DR severity per modified Davis staging: 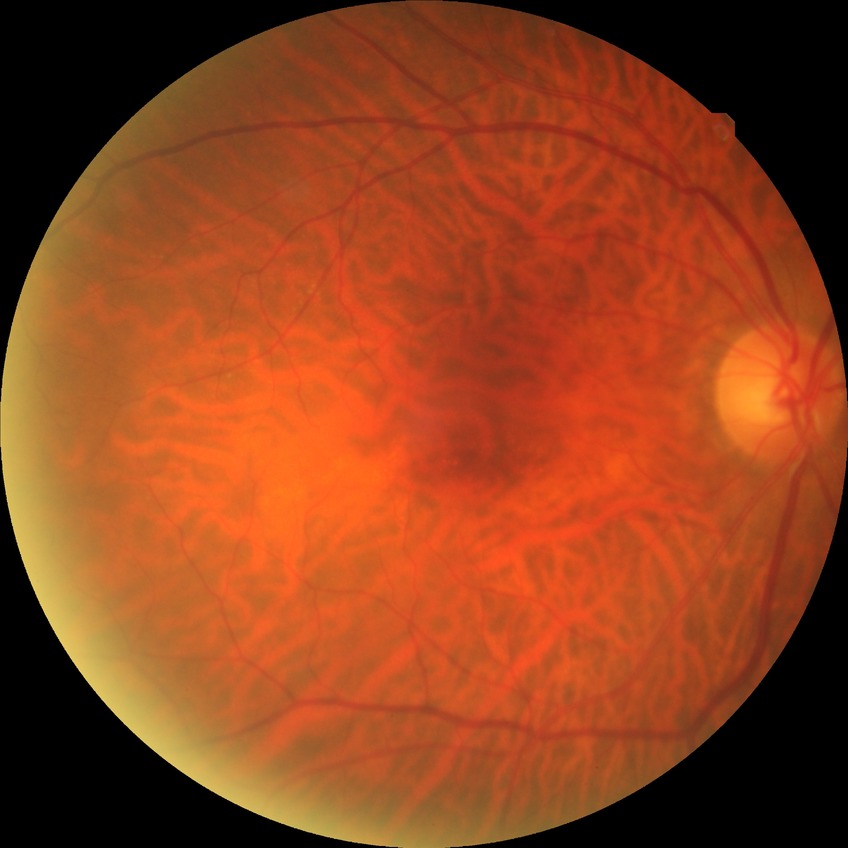

Diabetic retinopathy severity is no diabetic retinopathy.